45-degree field of view, 2352 x 1568 pixels, color fundus image: 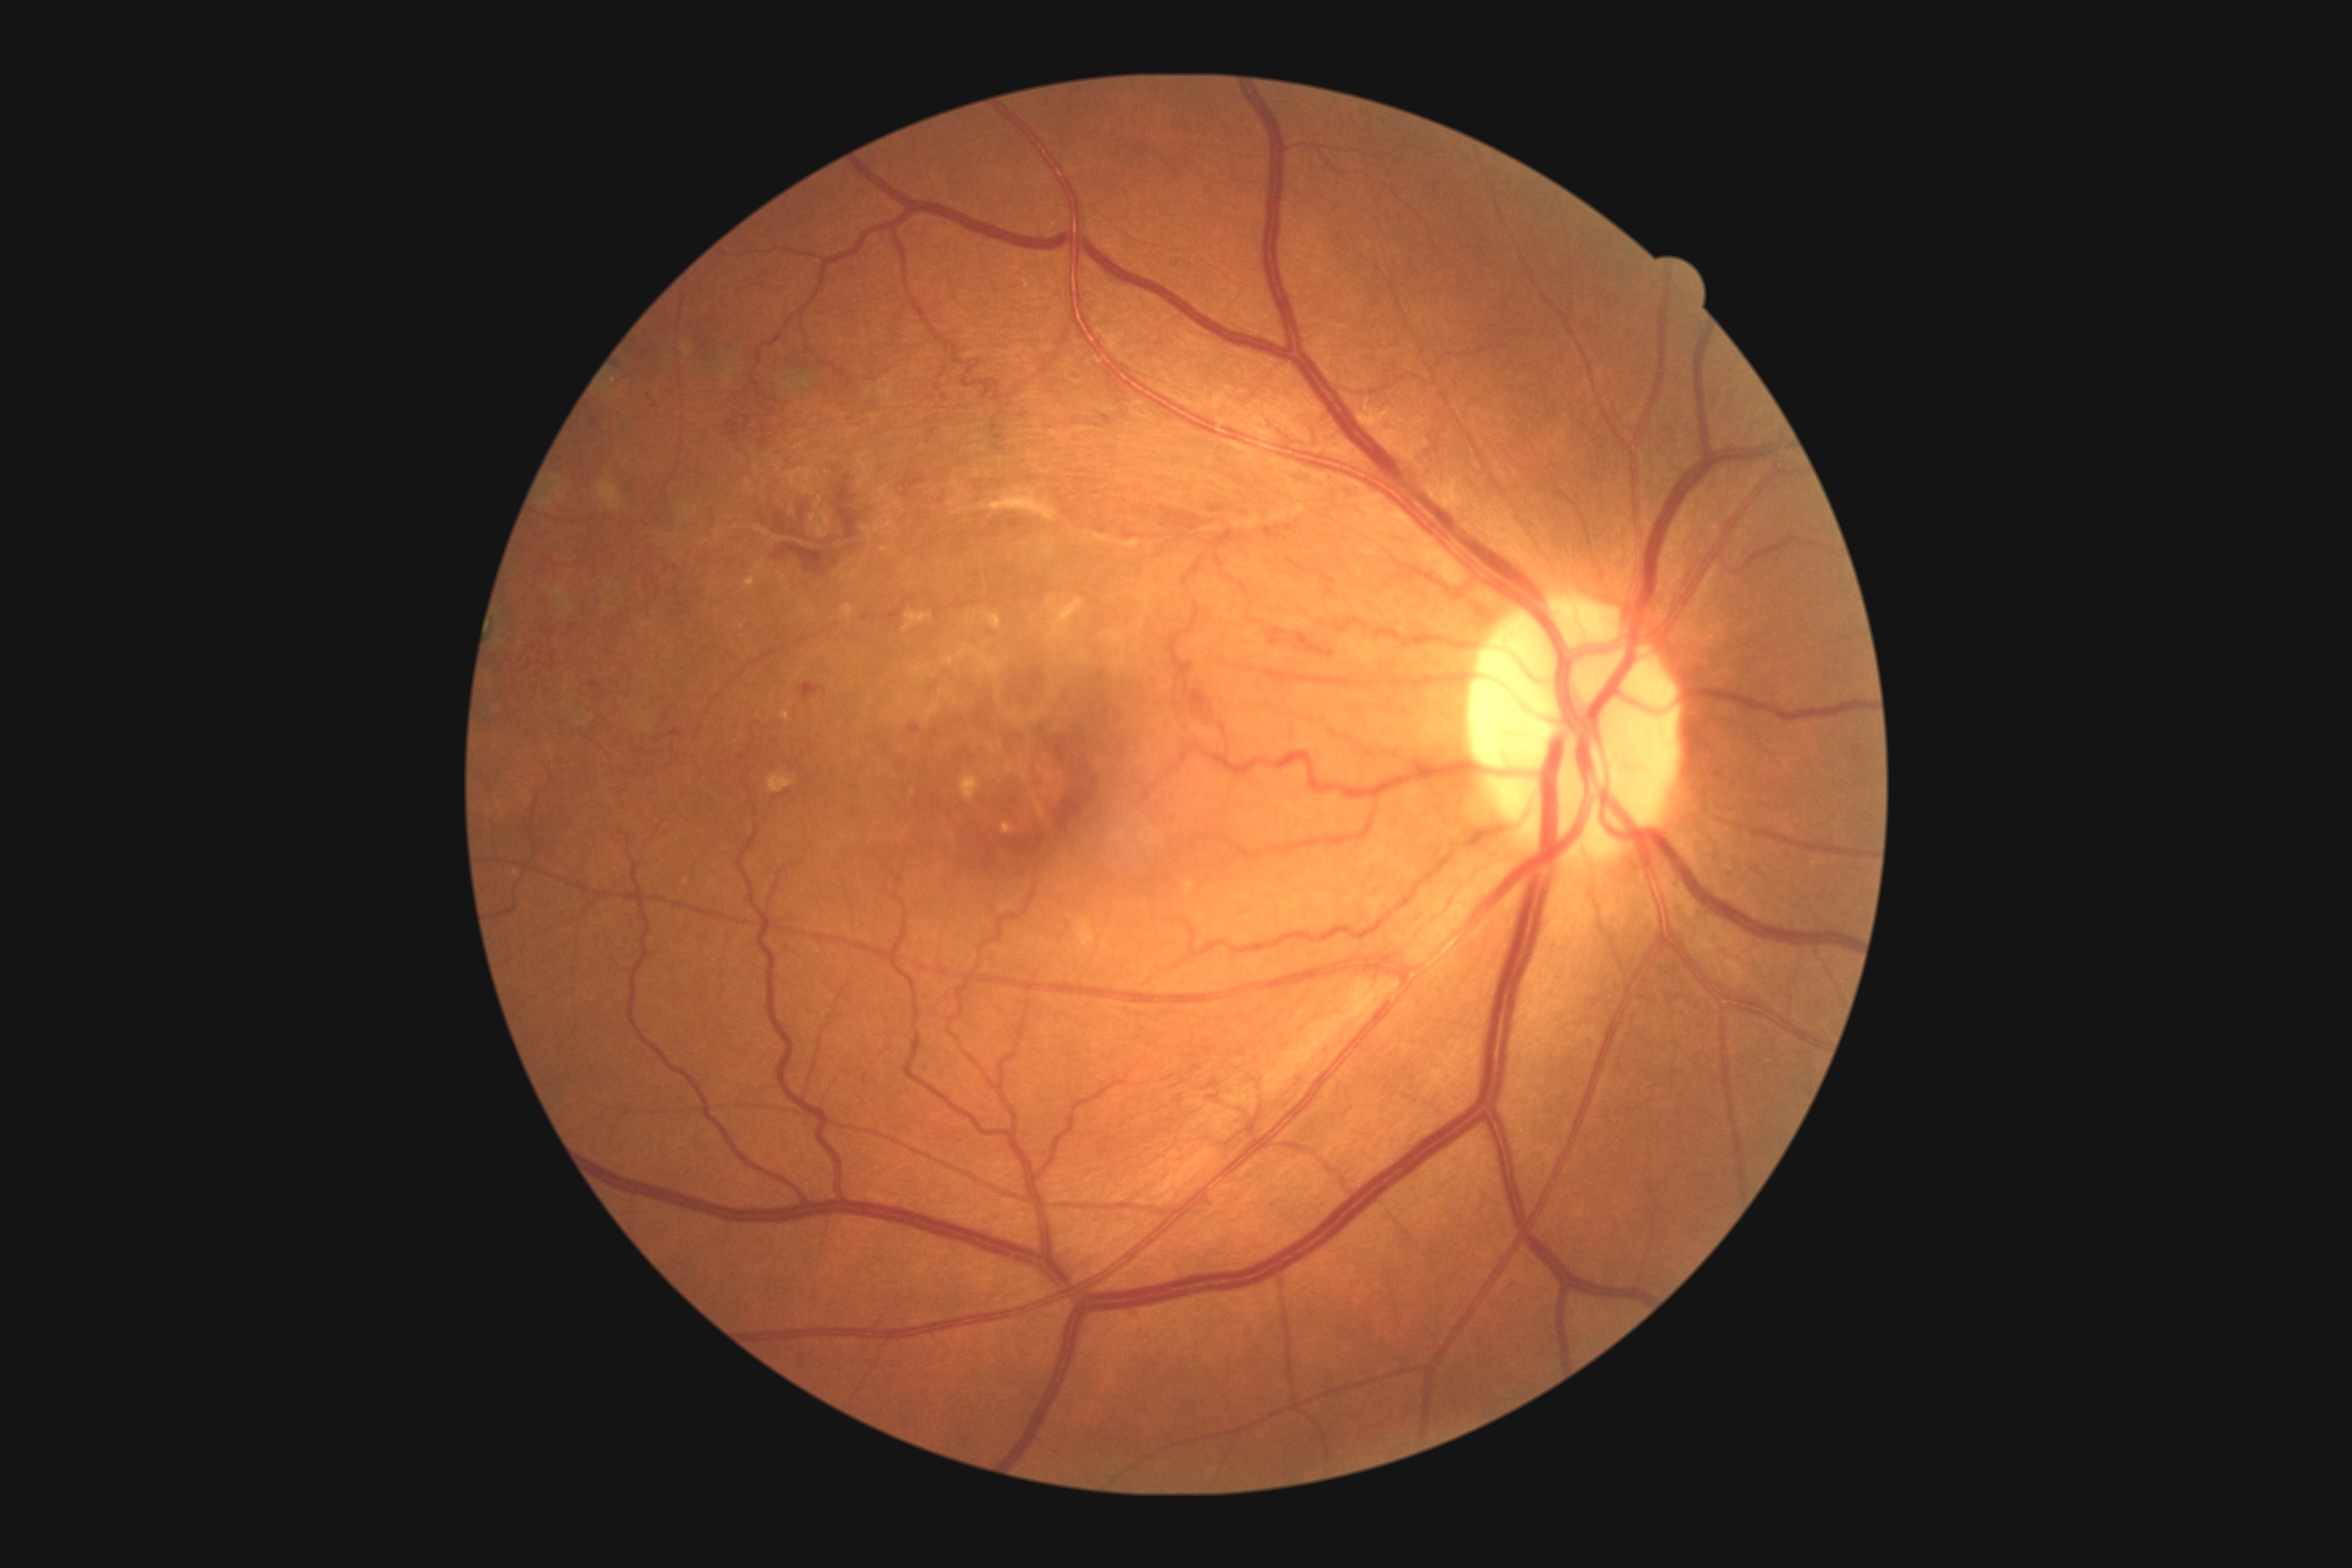 partial: true
dr_grade: 3
dr_grade_name: severe NPDR
lesions:
  he:
    - box(1268, 627, 1289, 645)
    - box(1104, 416, 1113, 424)
    - box(1264, 527, 1280, 538)
    - box(1280, 469, 1324, 489)
    - box(910, 725, 921, 734)
    - box(995, 435, 1006, 442)
    - box(936, 384, 941, 393)
    - box(761, 462, 876, 582)
    - box(899, 473, 923, 498)
    - box(591, 681, 600, 691)
    - box(919, 1063, 930, 1073)
    - box(1181, 685, 1230, 730)
  he_small_centers:
    - [655,407]
    - [1287,528]
    - [1245,514]
    - [1098,426]
  se: []
  ex:
    - box(1003, 823, 1014, 836)
    - box(843, 605, 854, 620)
    - box(985, 612, 1003, 631)
    - box(743, 576, 761, 591)
    - box(903, 611, 934, 632)
    - box(781, 710, 790, 723)
    - box(756, 565, 761, 573)
    - box(959, 774, 983, 801)
  ex_small_centers:
    - [884,550]
    - [614,381]
  ma: []